640 by 480 pixels; Clarity RetCam 3, 130° FOV; wide-field contact fundus photograph of an infant — 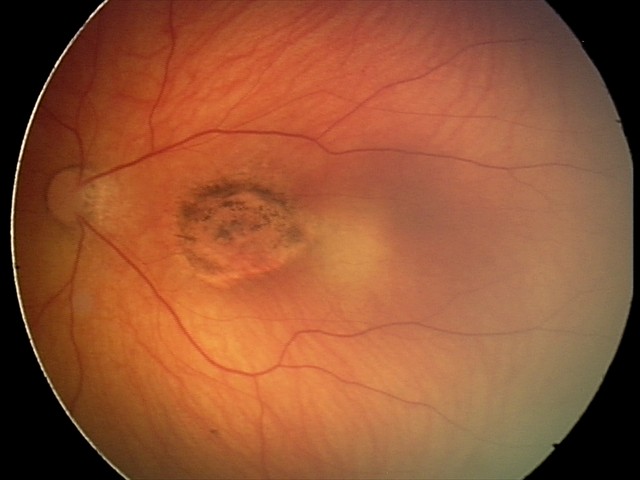

Series diagnosed as toxoplasmosis chorioretinitis.